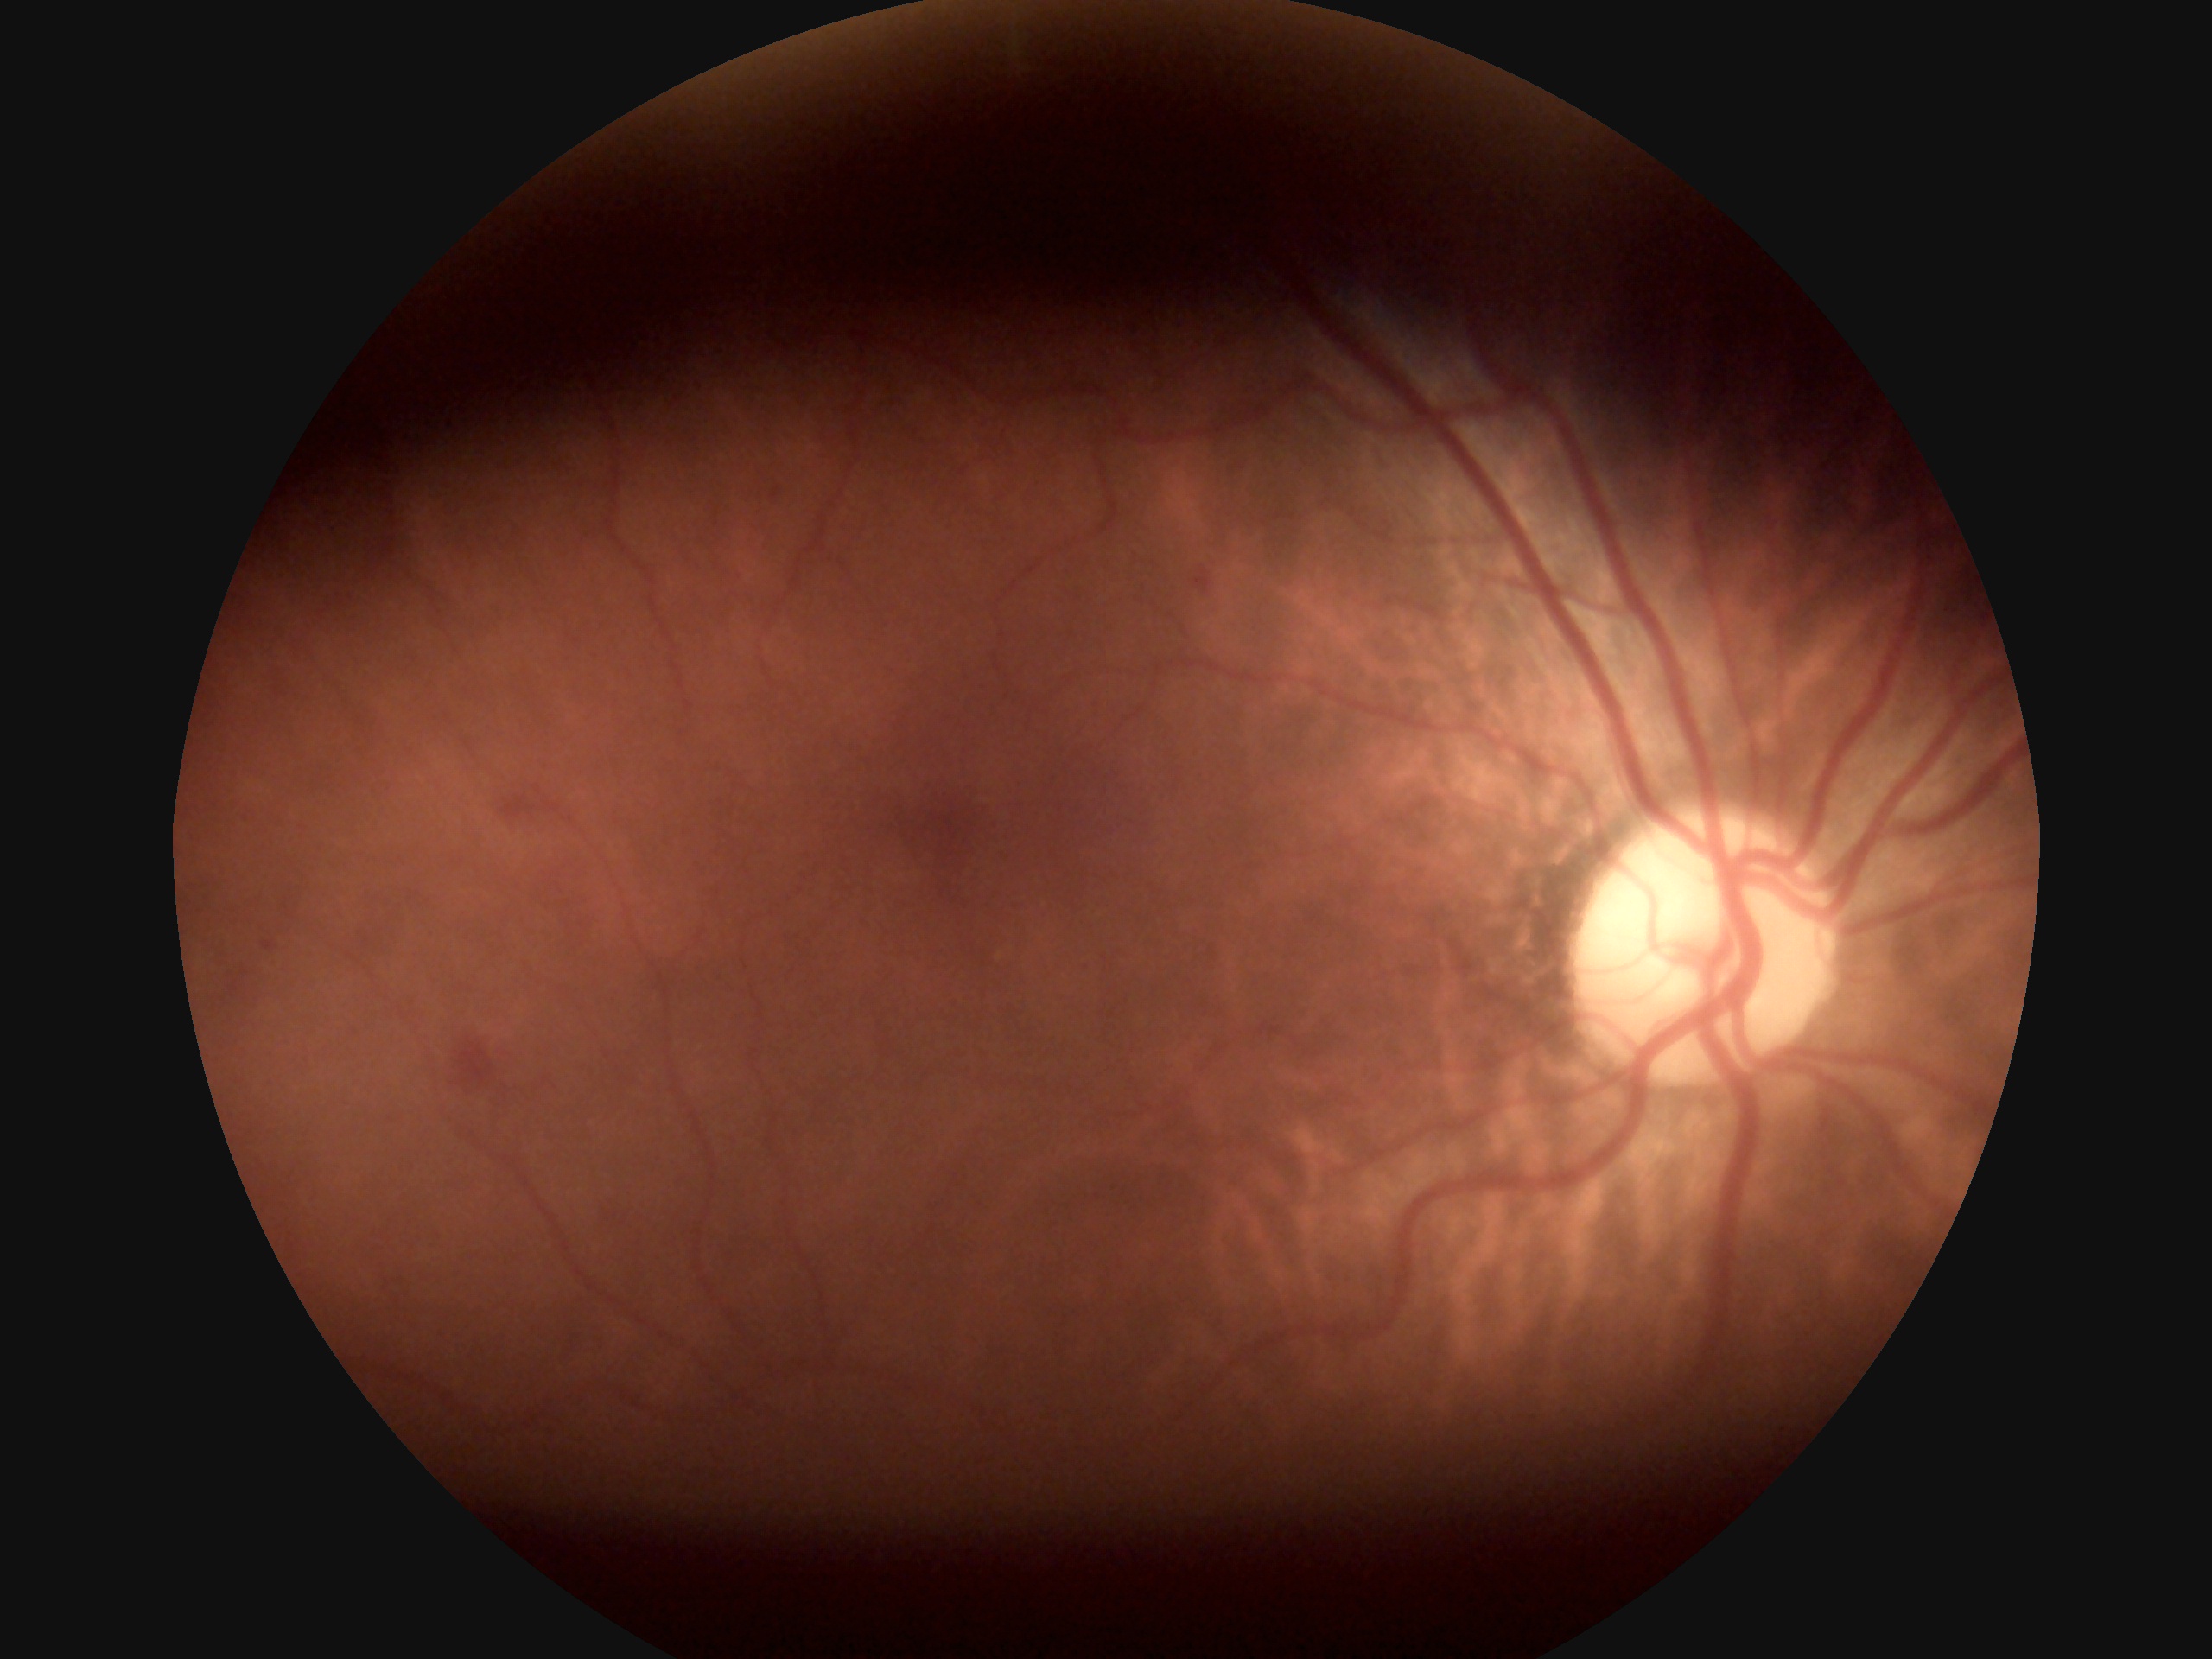

diabetic retinopathy (DR): 2/4 — more than just microaneurysms but less than severe NPDR.